Camera: NIDEK AFC-230
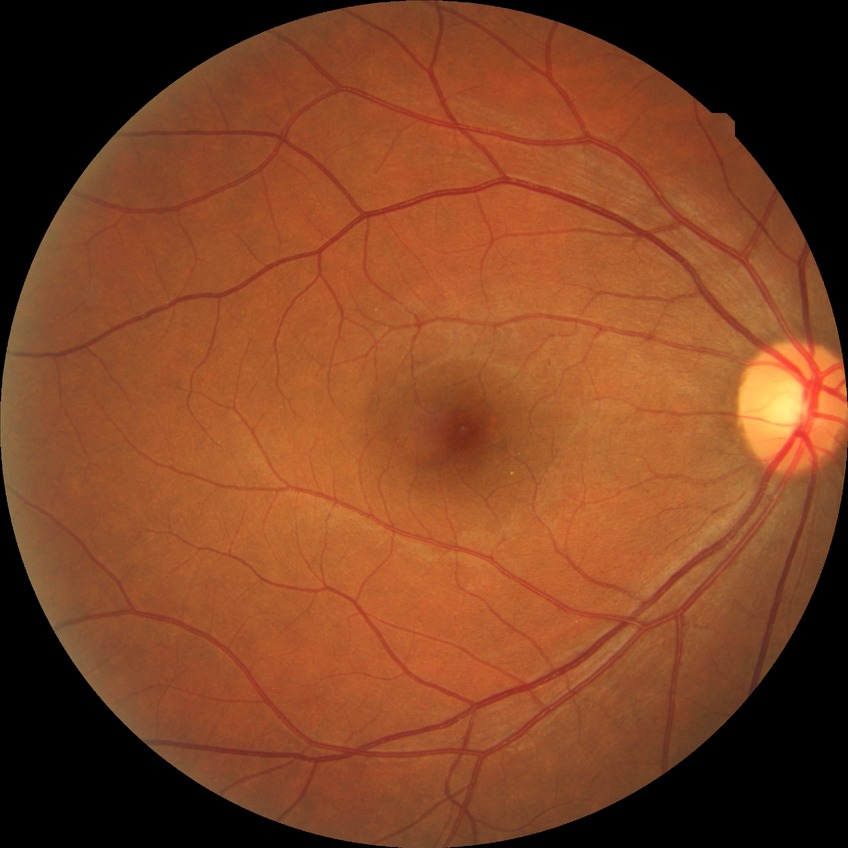
Diabetic retinopathy (DR): SDR (simple diabetic retinopathy).